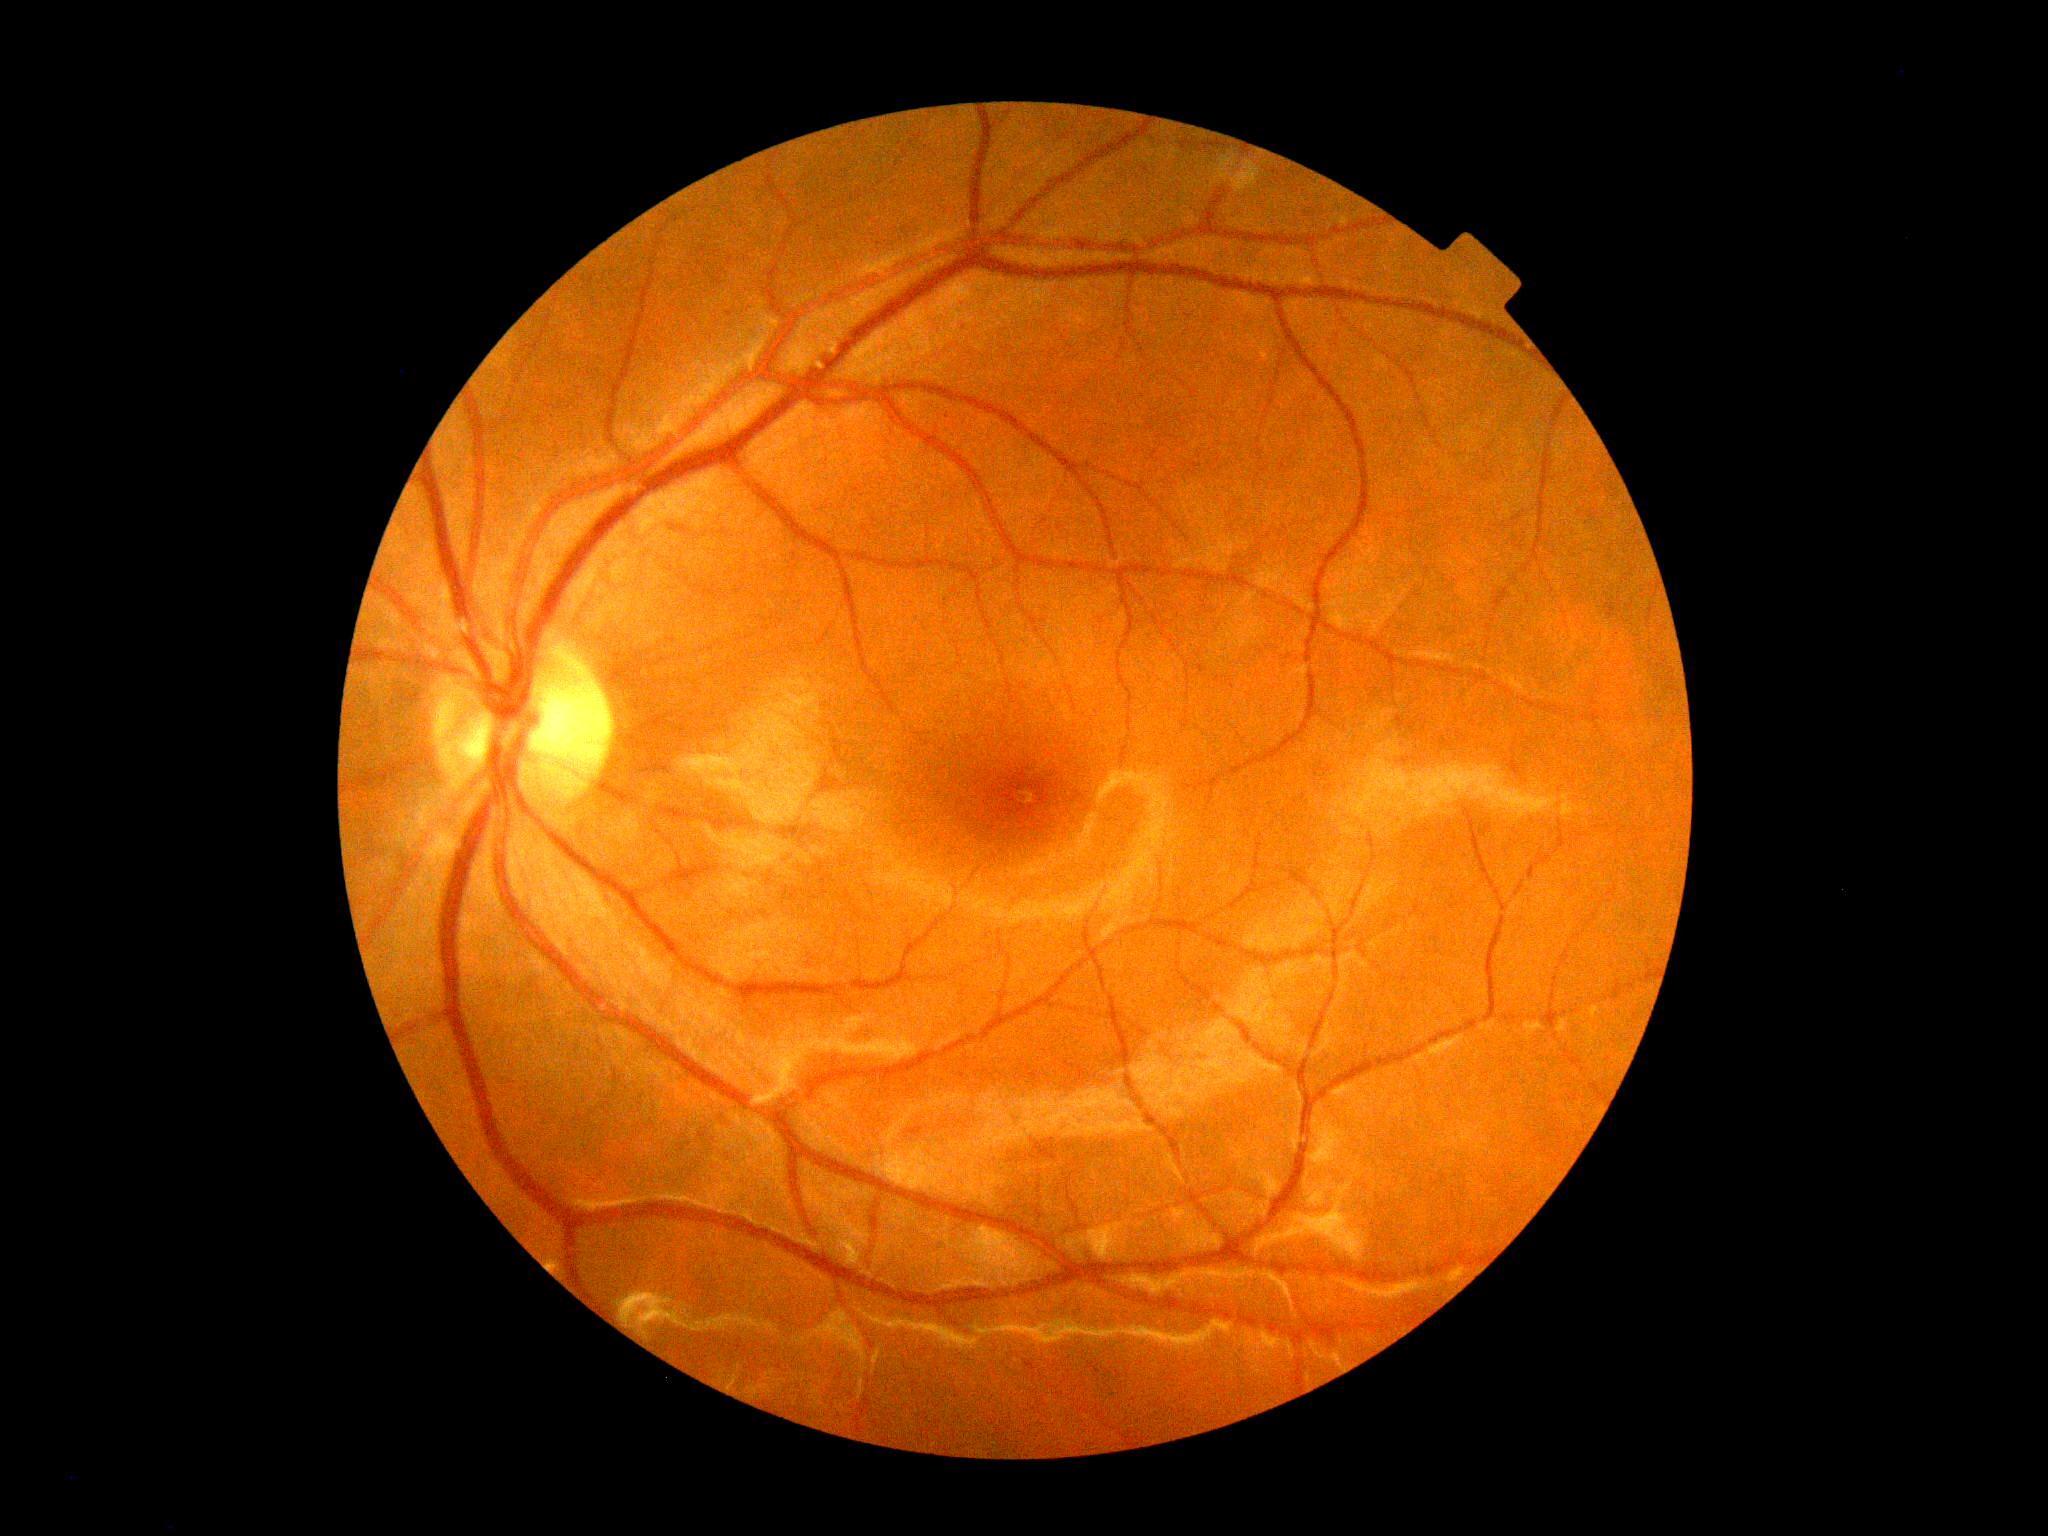

No DR findings.
Retinopathy is no apparent diabetic retinopathy (grade 0).